1932 by 1916 pixels
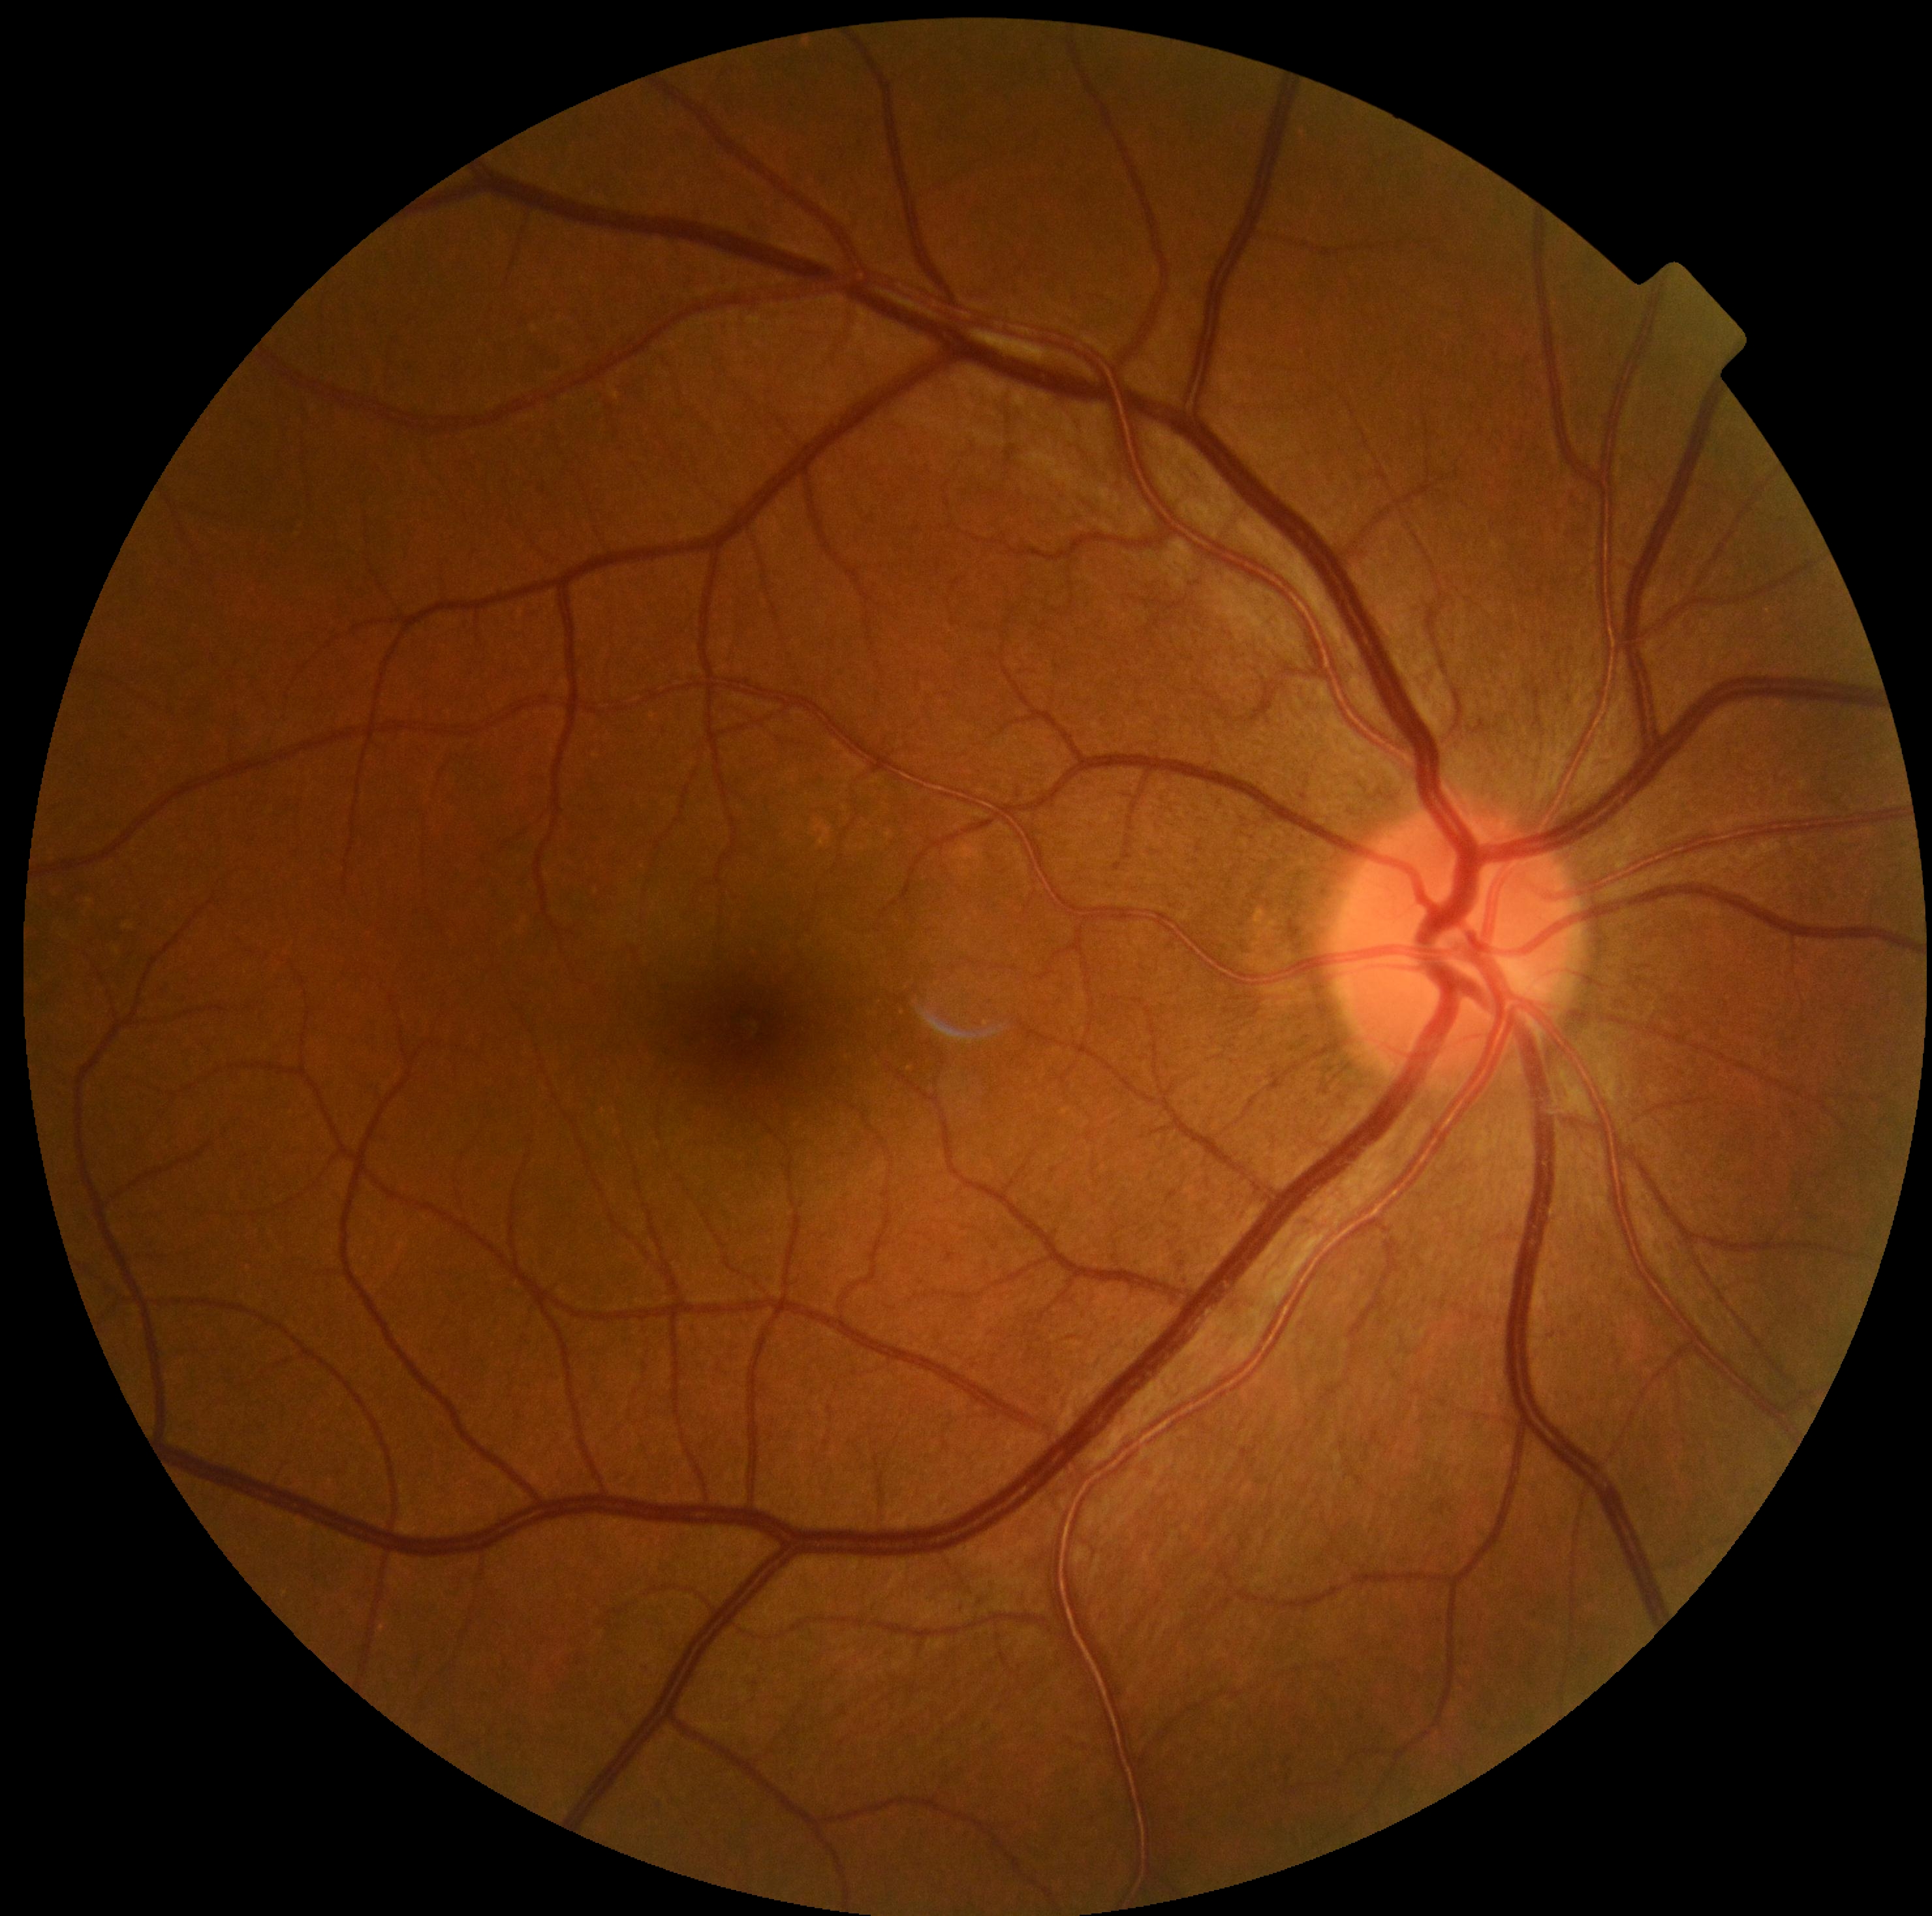

Diabetic retinopathy (DR) is no apparent diabetic retinopathy (grade 0) — no visible signs of diabetic retinopathy.